2048 by 1536 pixels; color fundus photograph; 45° field of view: 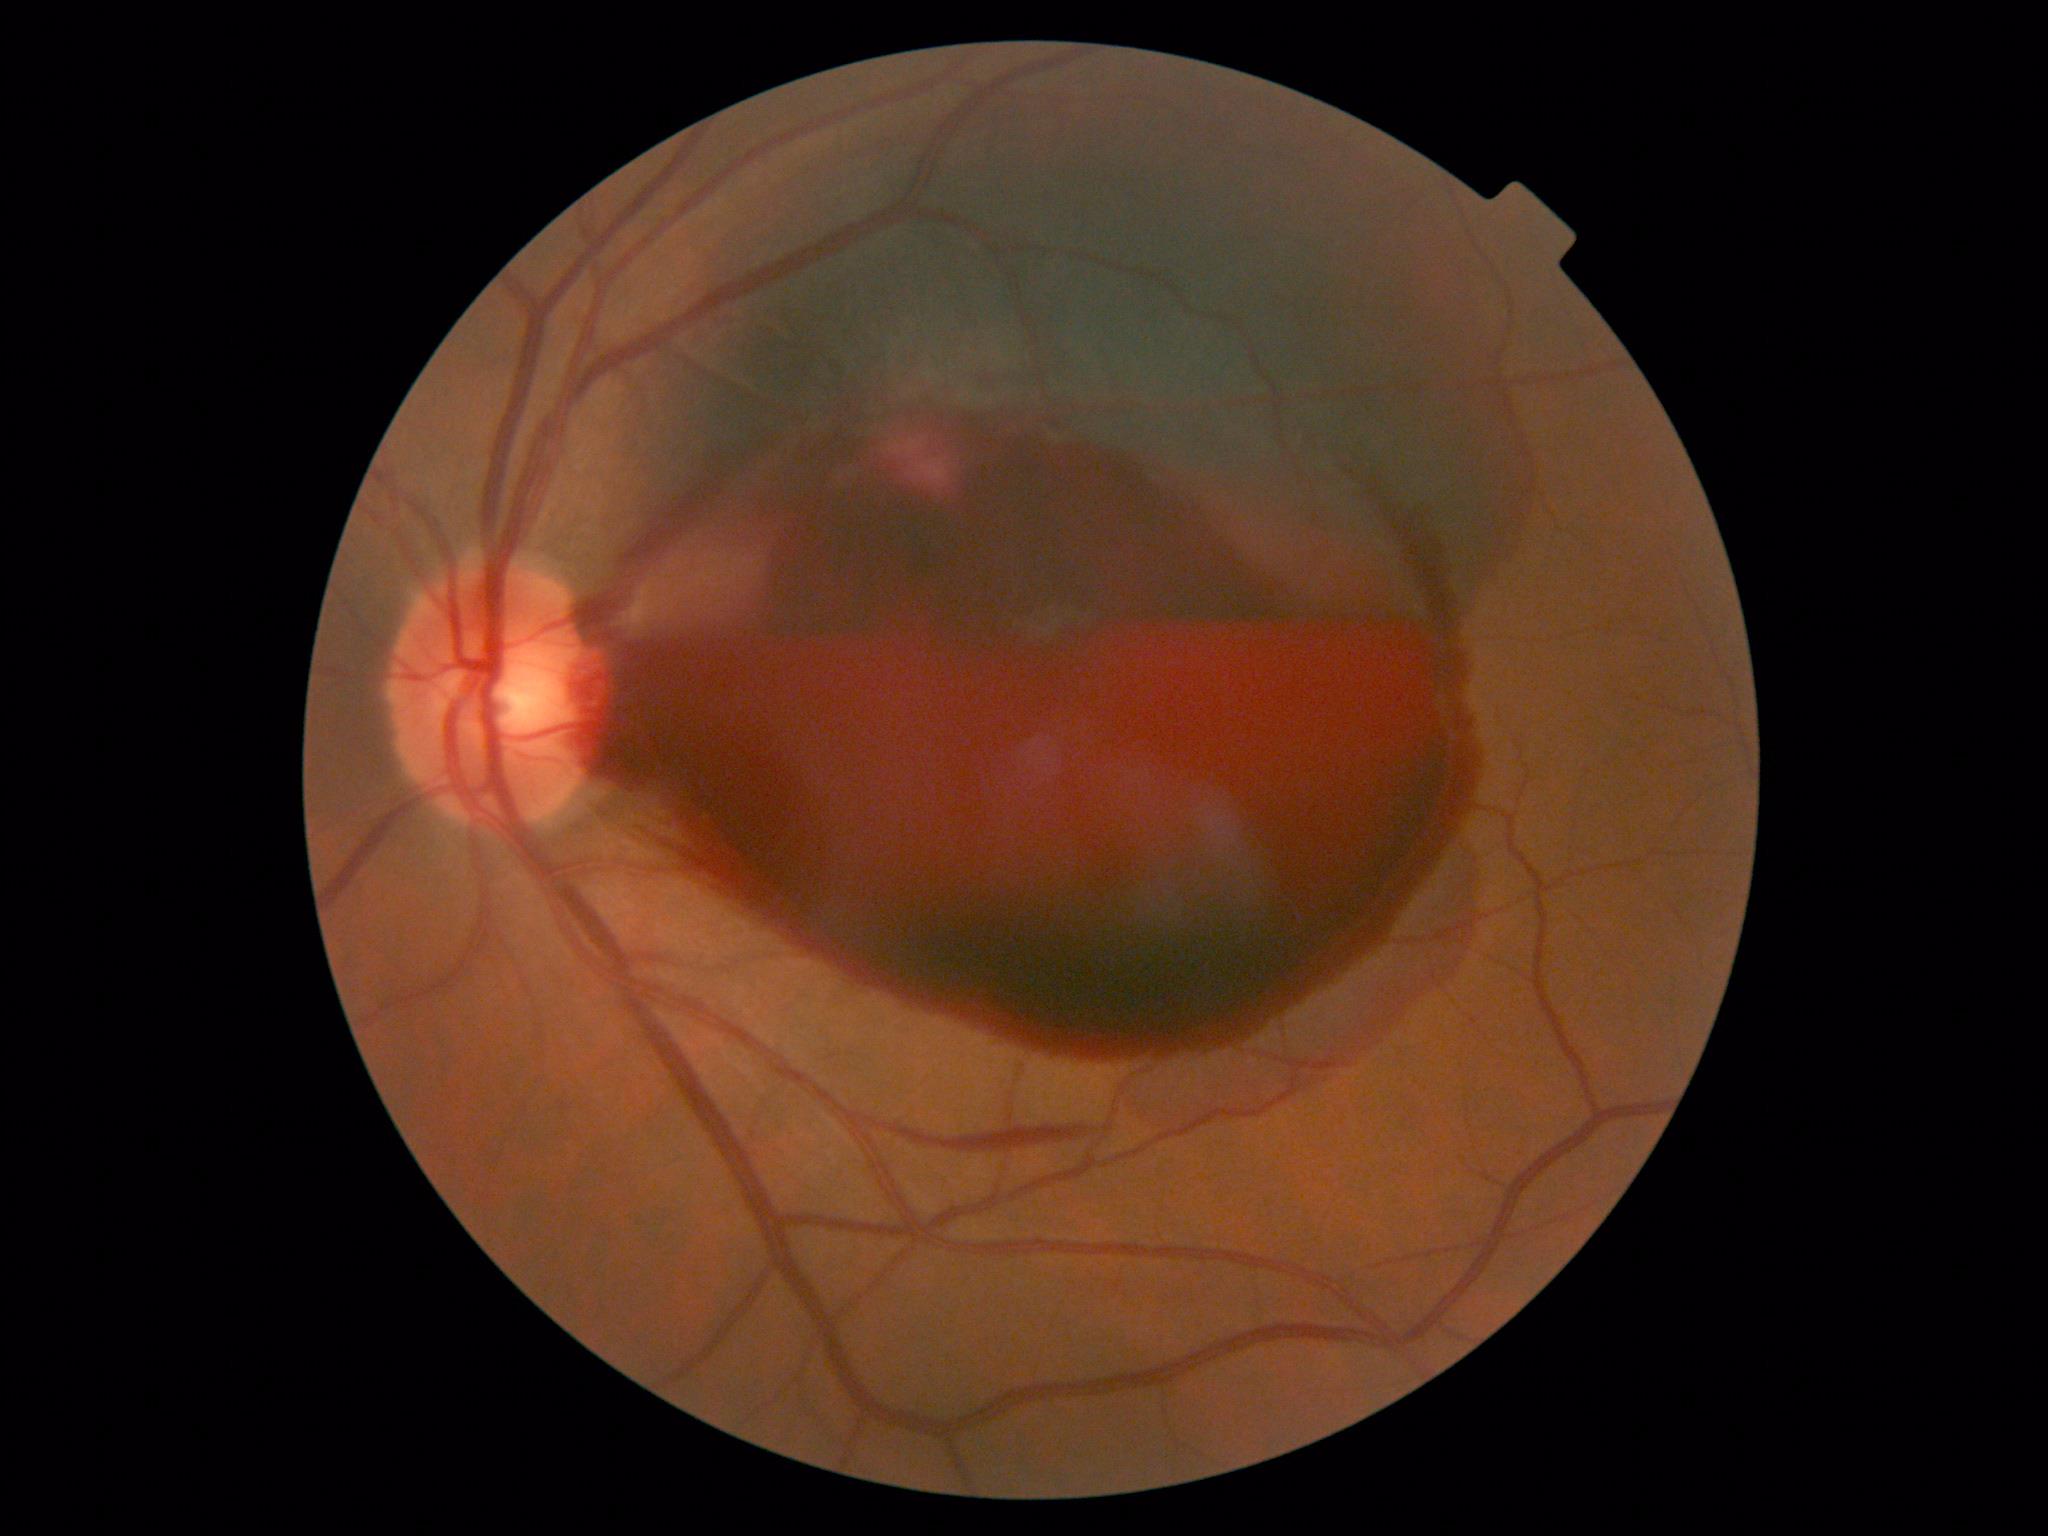

retinopathy: proliferative diabetic retinopathy (grade 4) — neovascularization and/or vitreous/pre-retinal hemorrhage.